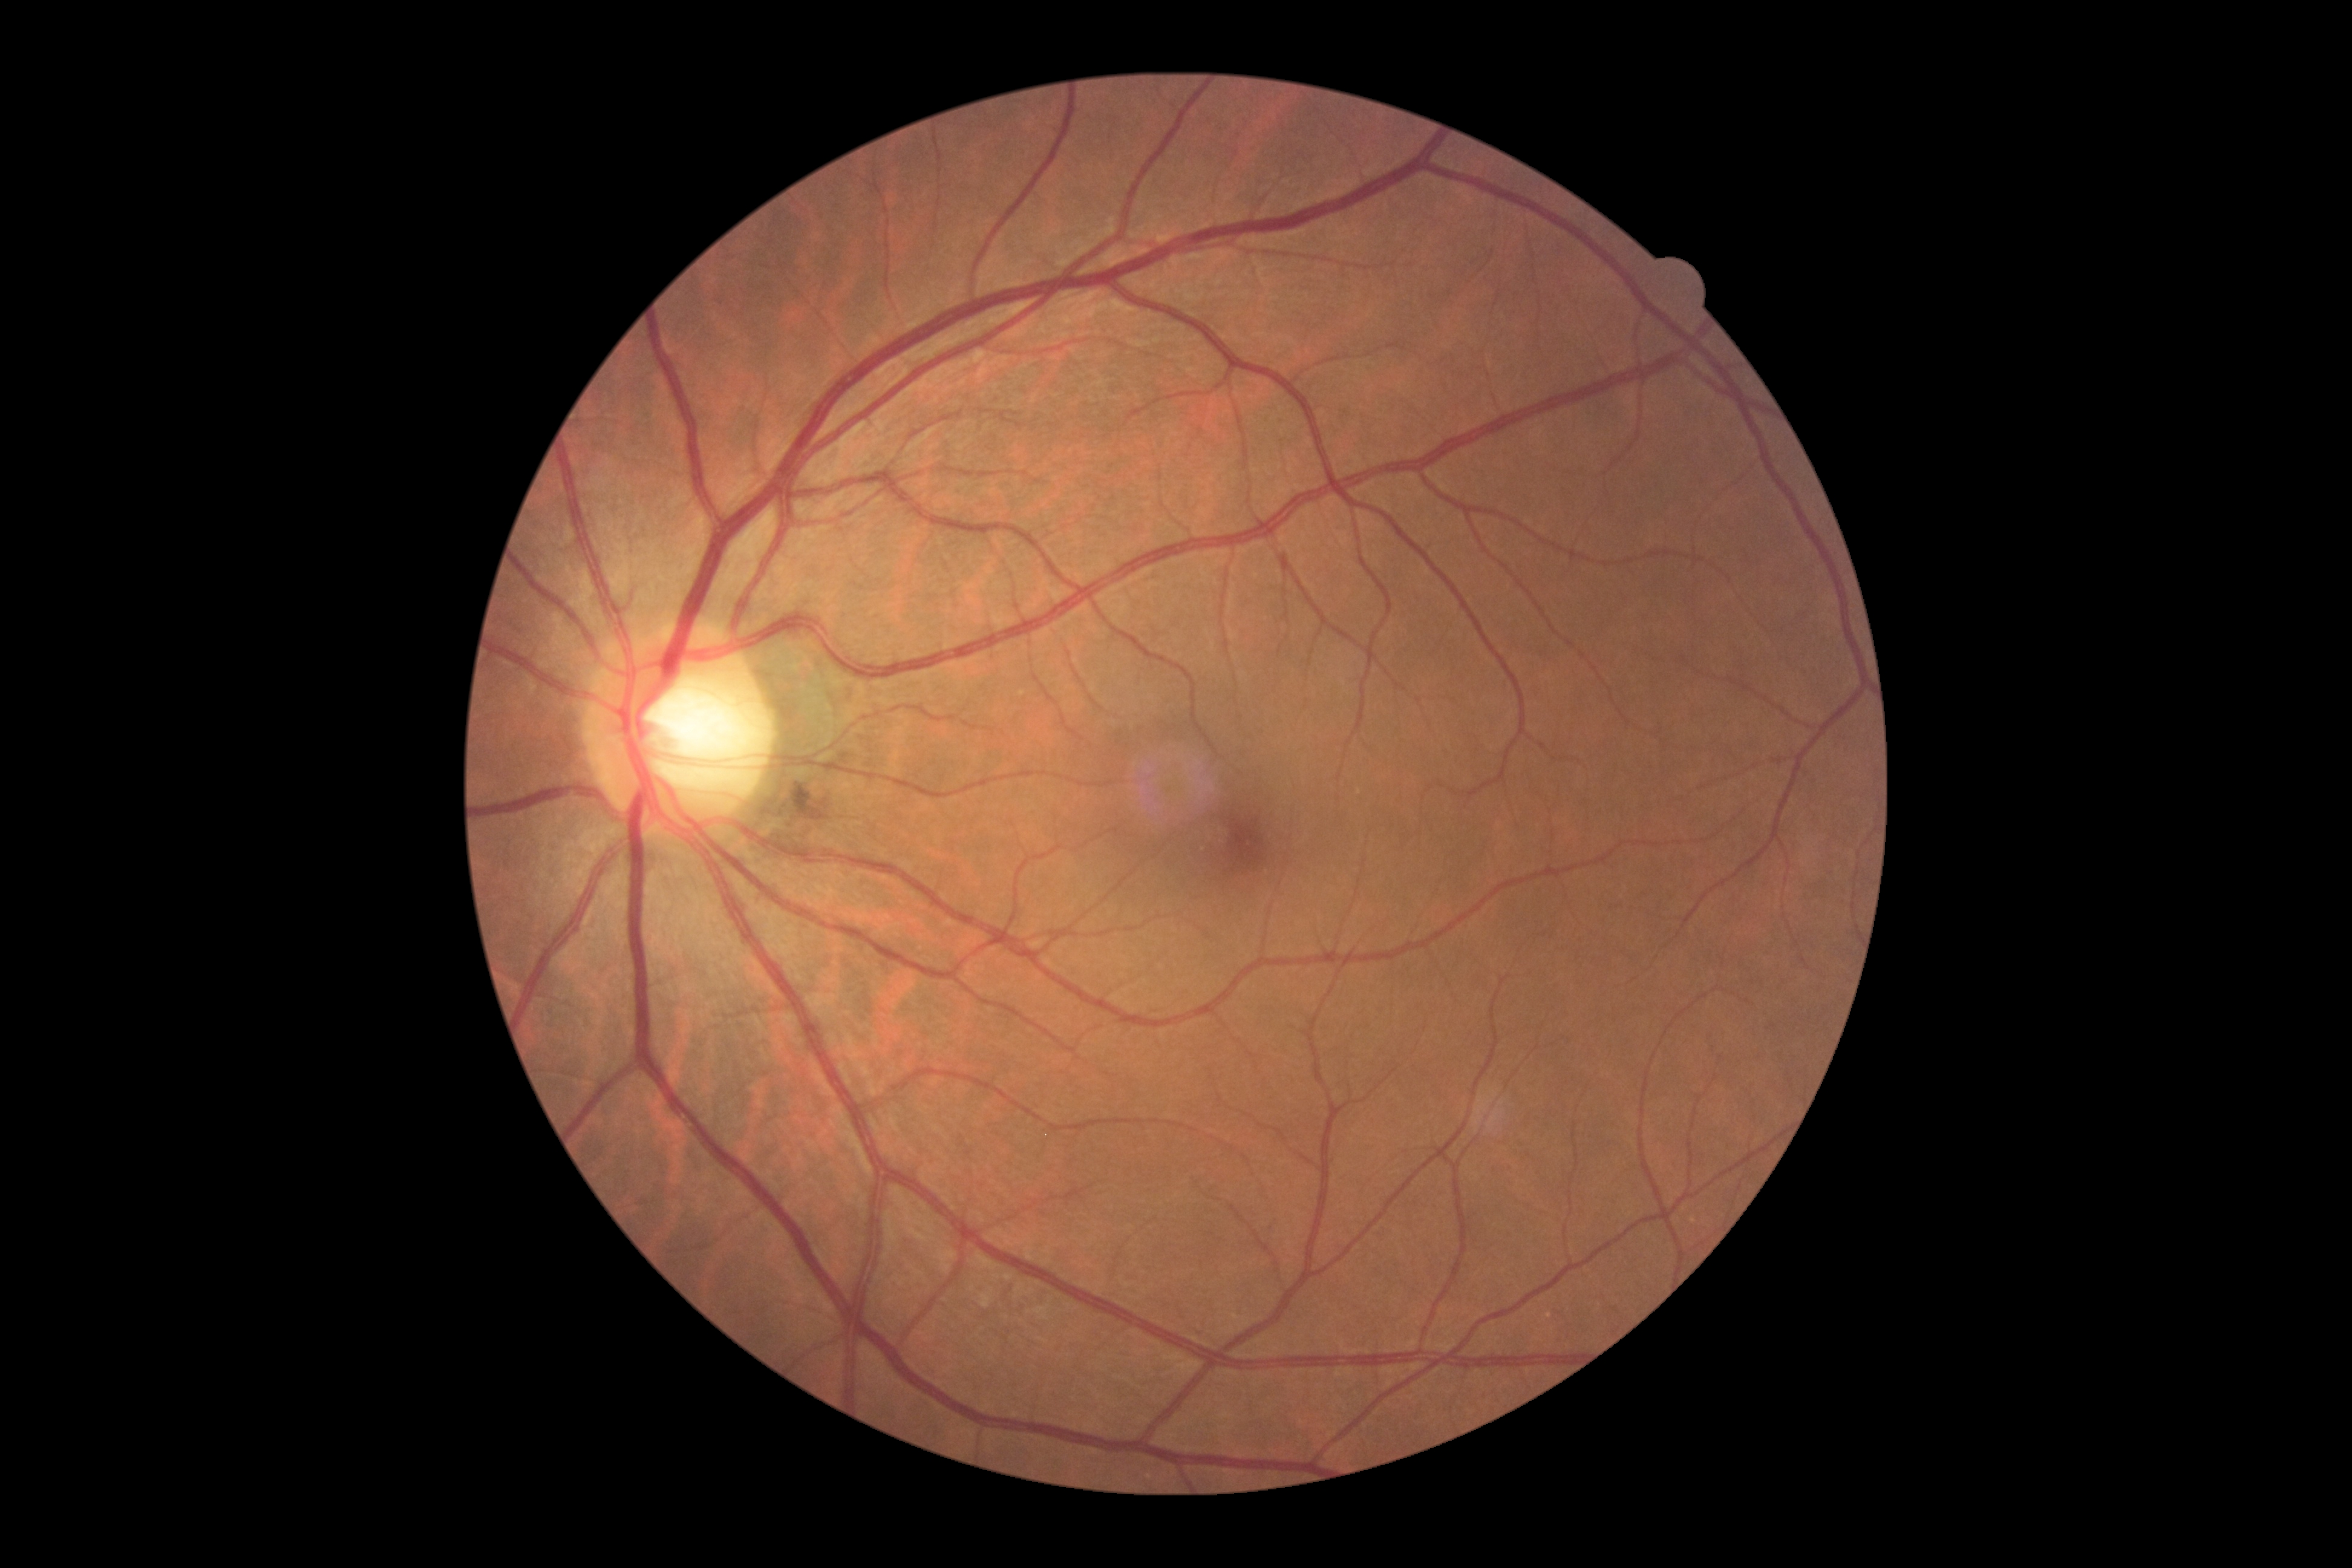

retinopathy grade=0 (no apparent retinopathy).